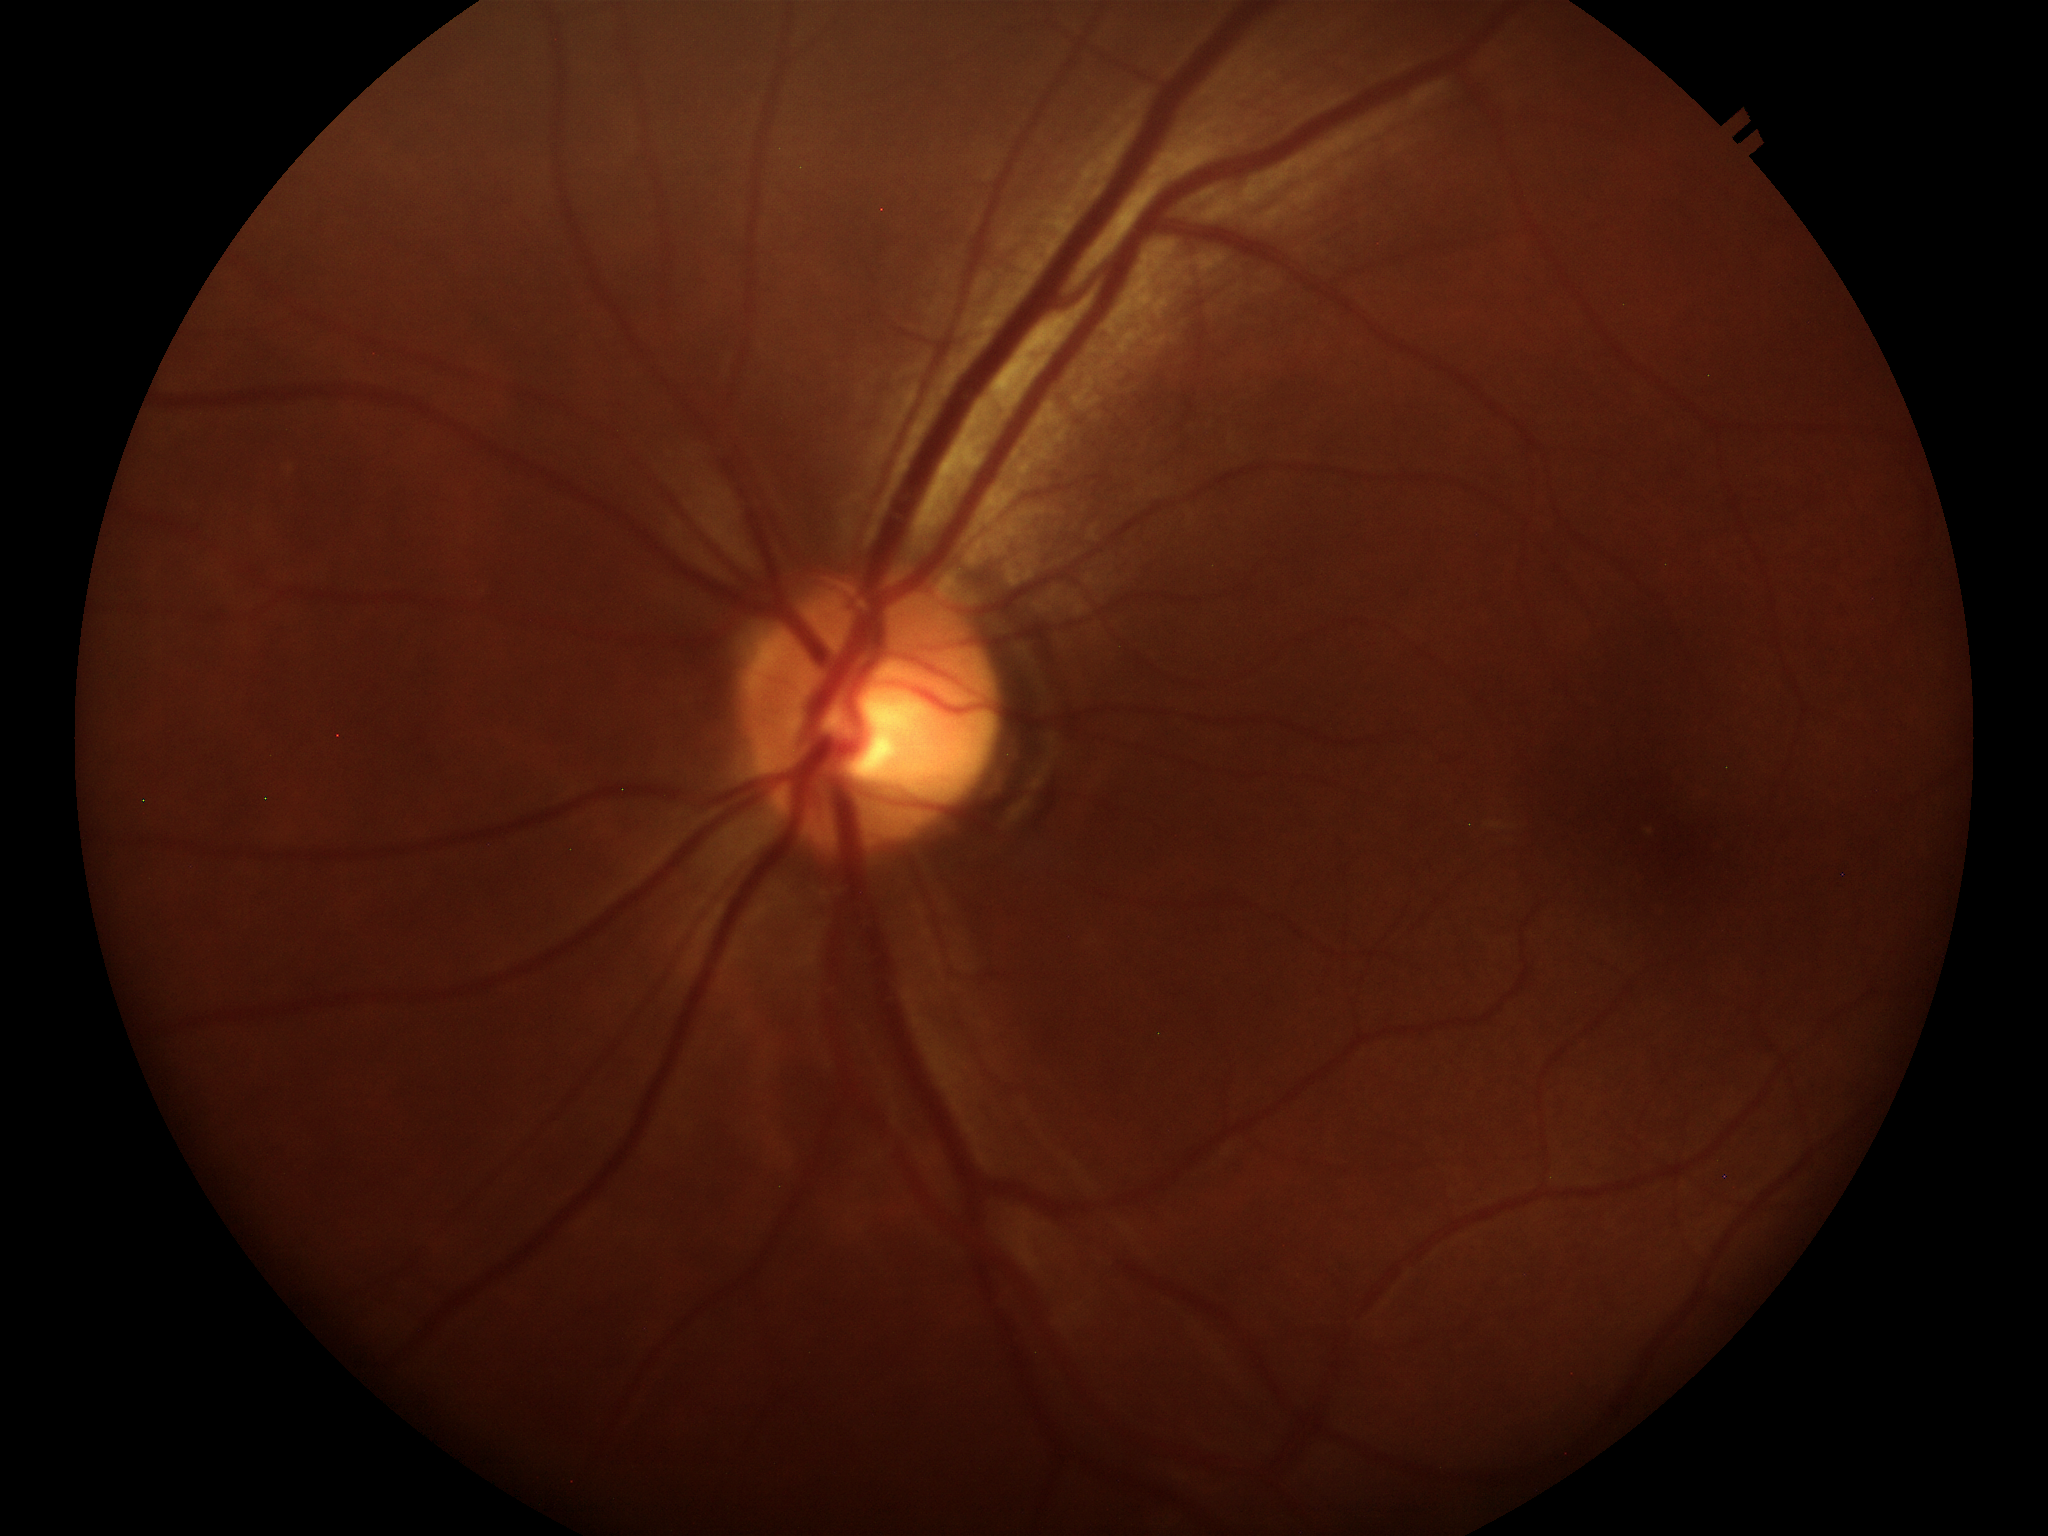 Annotations:
- Glaucoma impression: no suspicious findings
- vertical cup-to-disc ratio (VCDR): 0.51
- horizontal cup-to-disc ratio (HCDR): 0.49